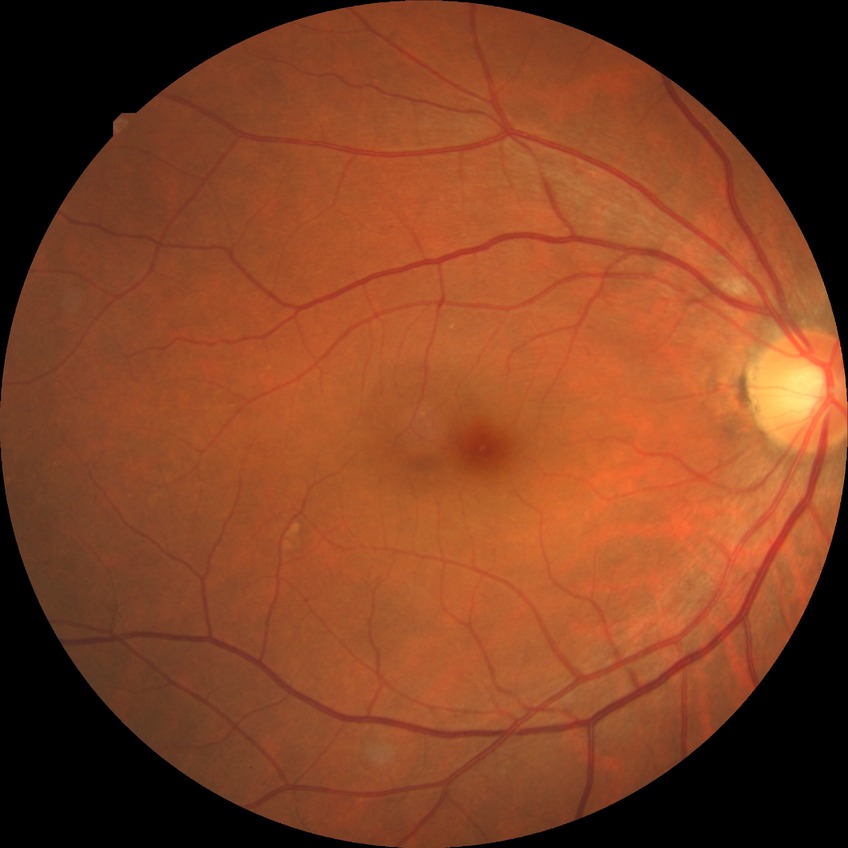 retinopathy grade = simple diabetic retinopathy